Ultra-widefield (UWF) fundus image: 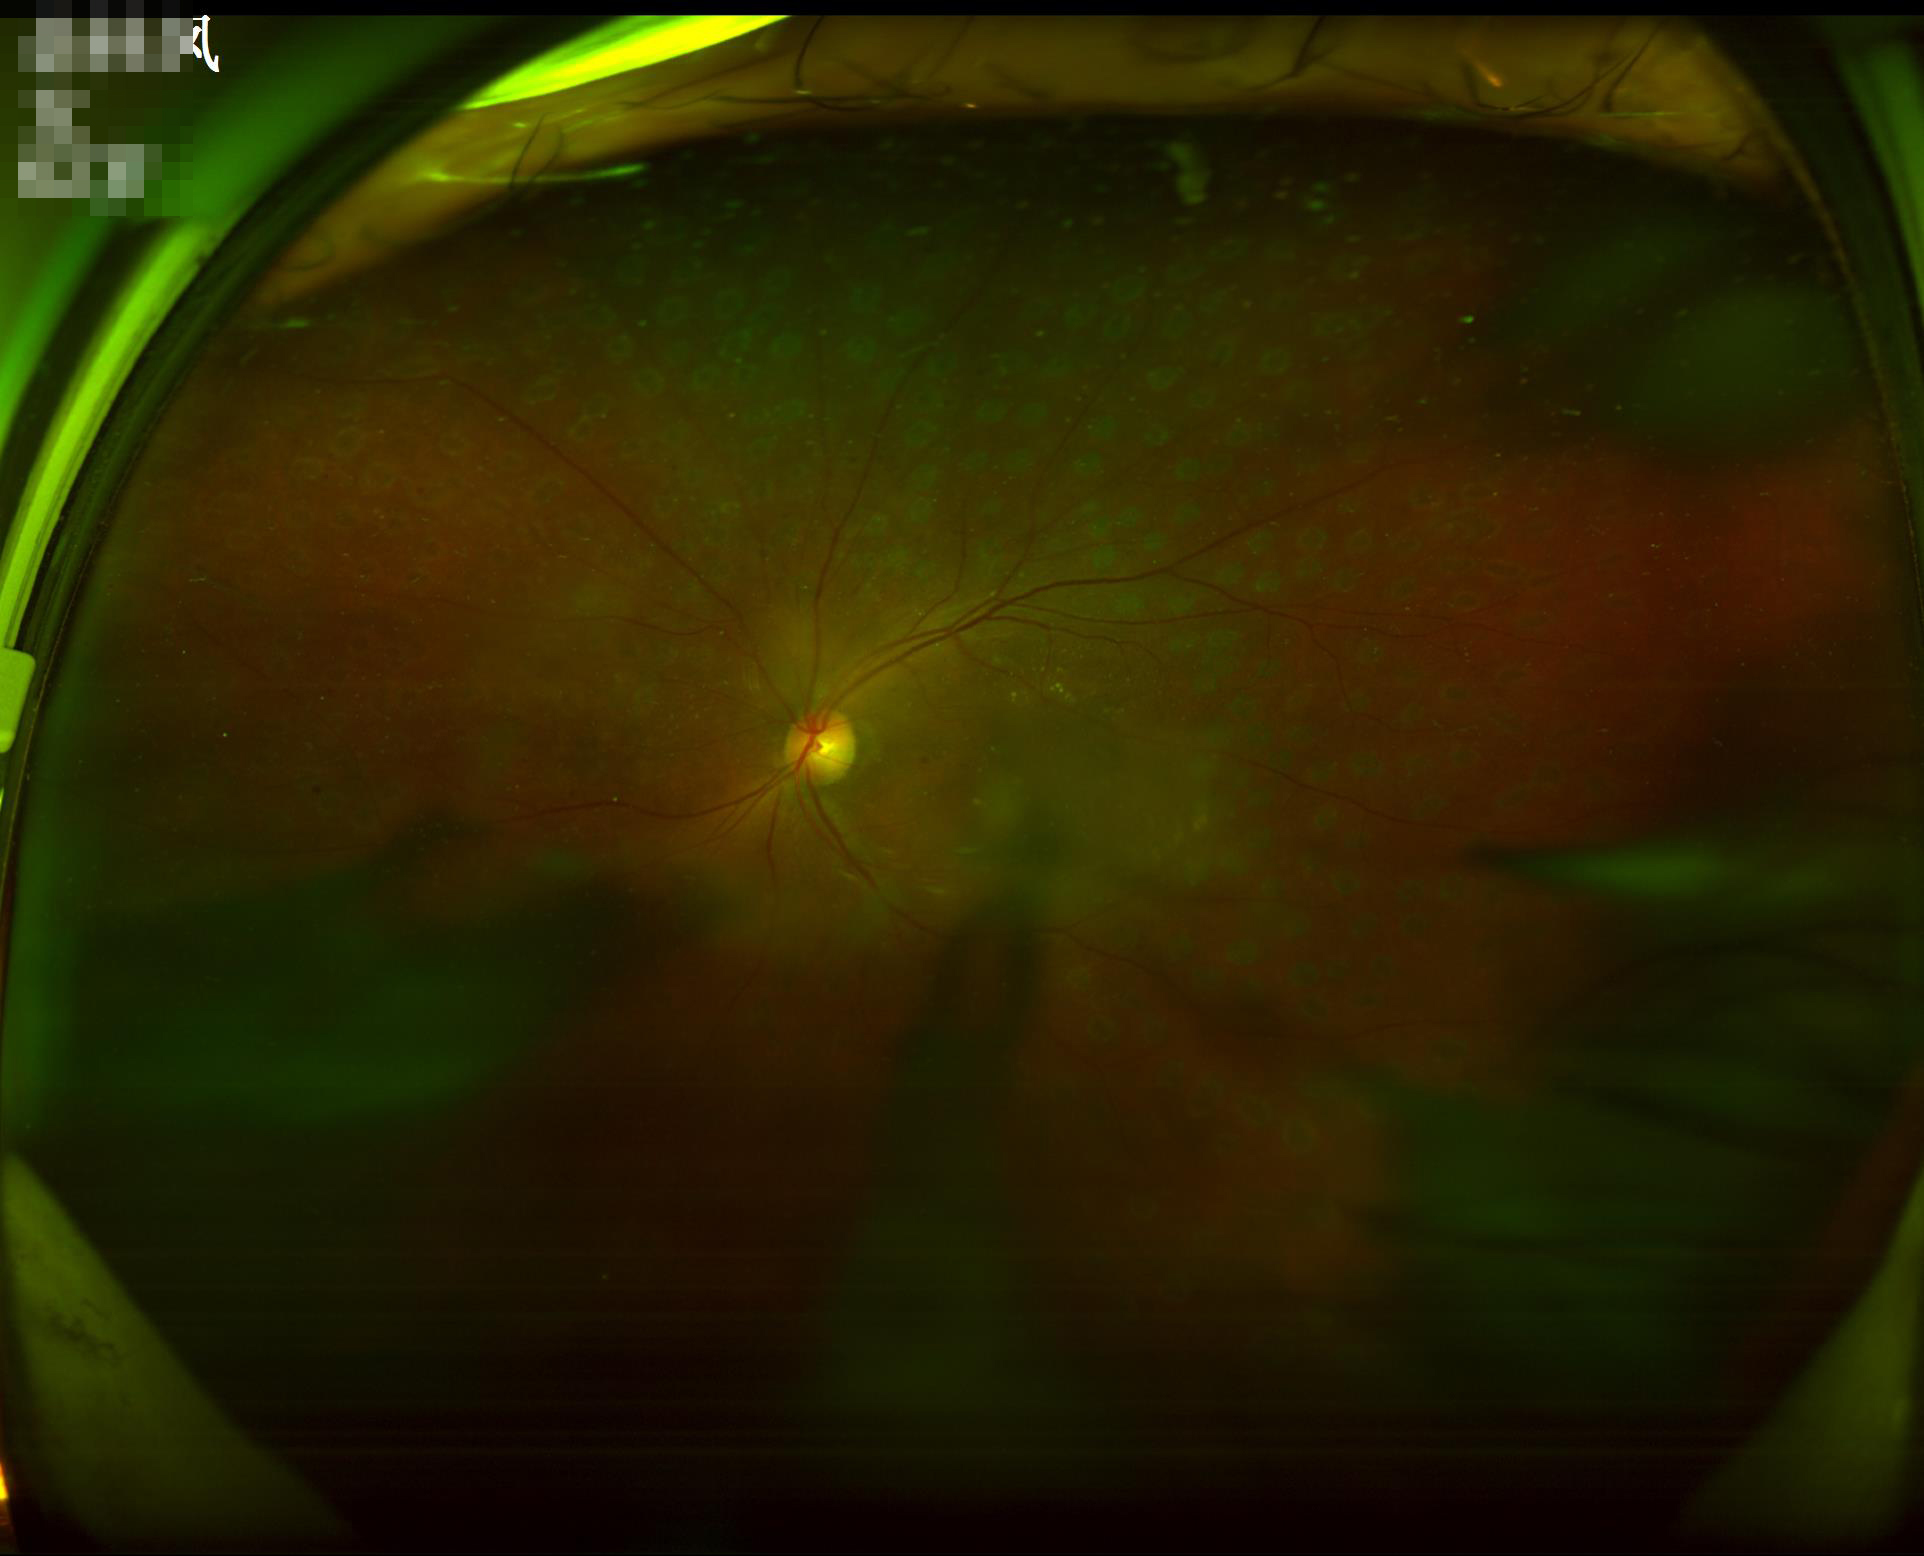 Image quality assessment: contrast: satisfactory | illumination/color: poor | overall: poor | focus: blurry.